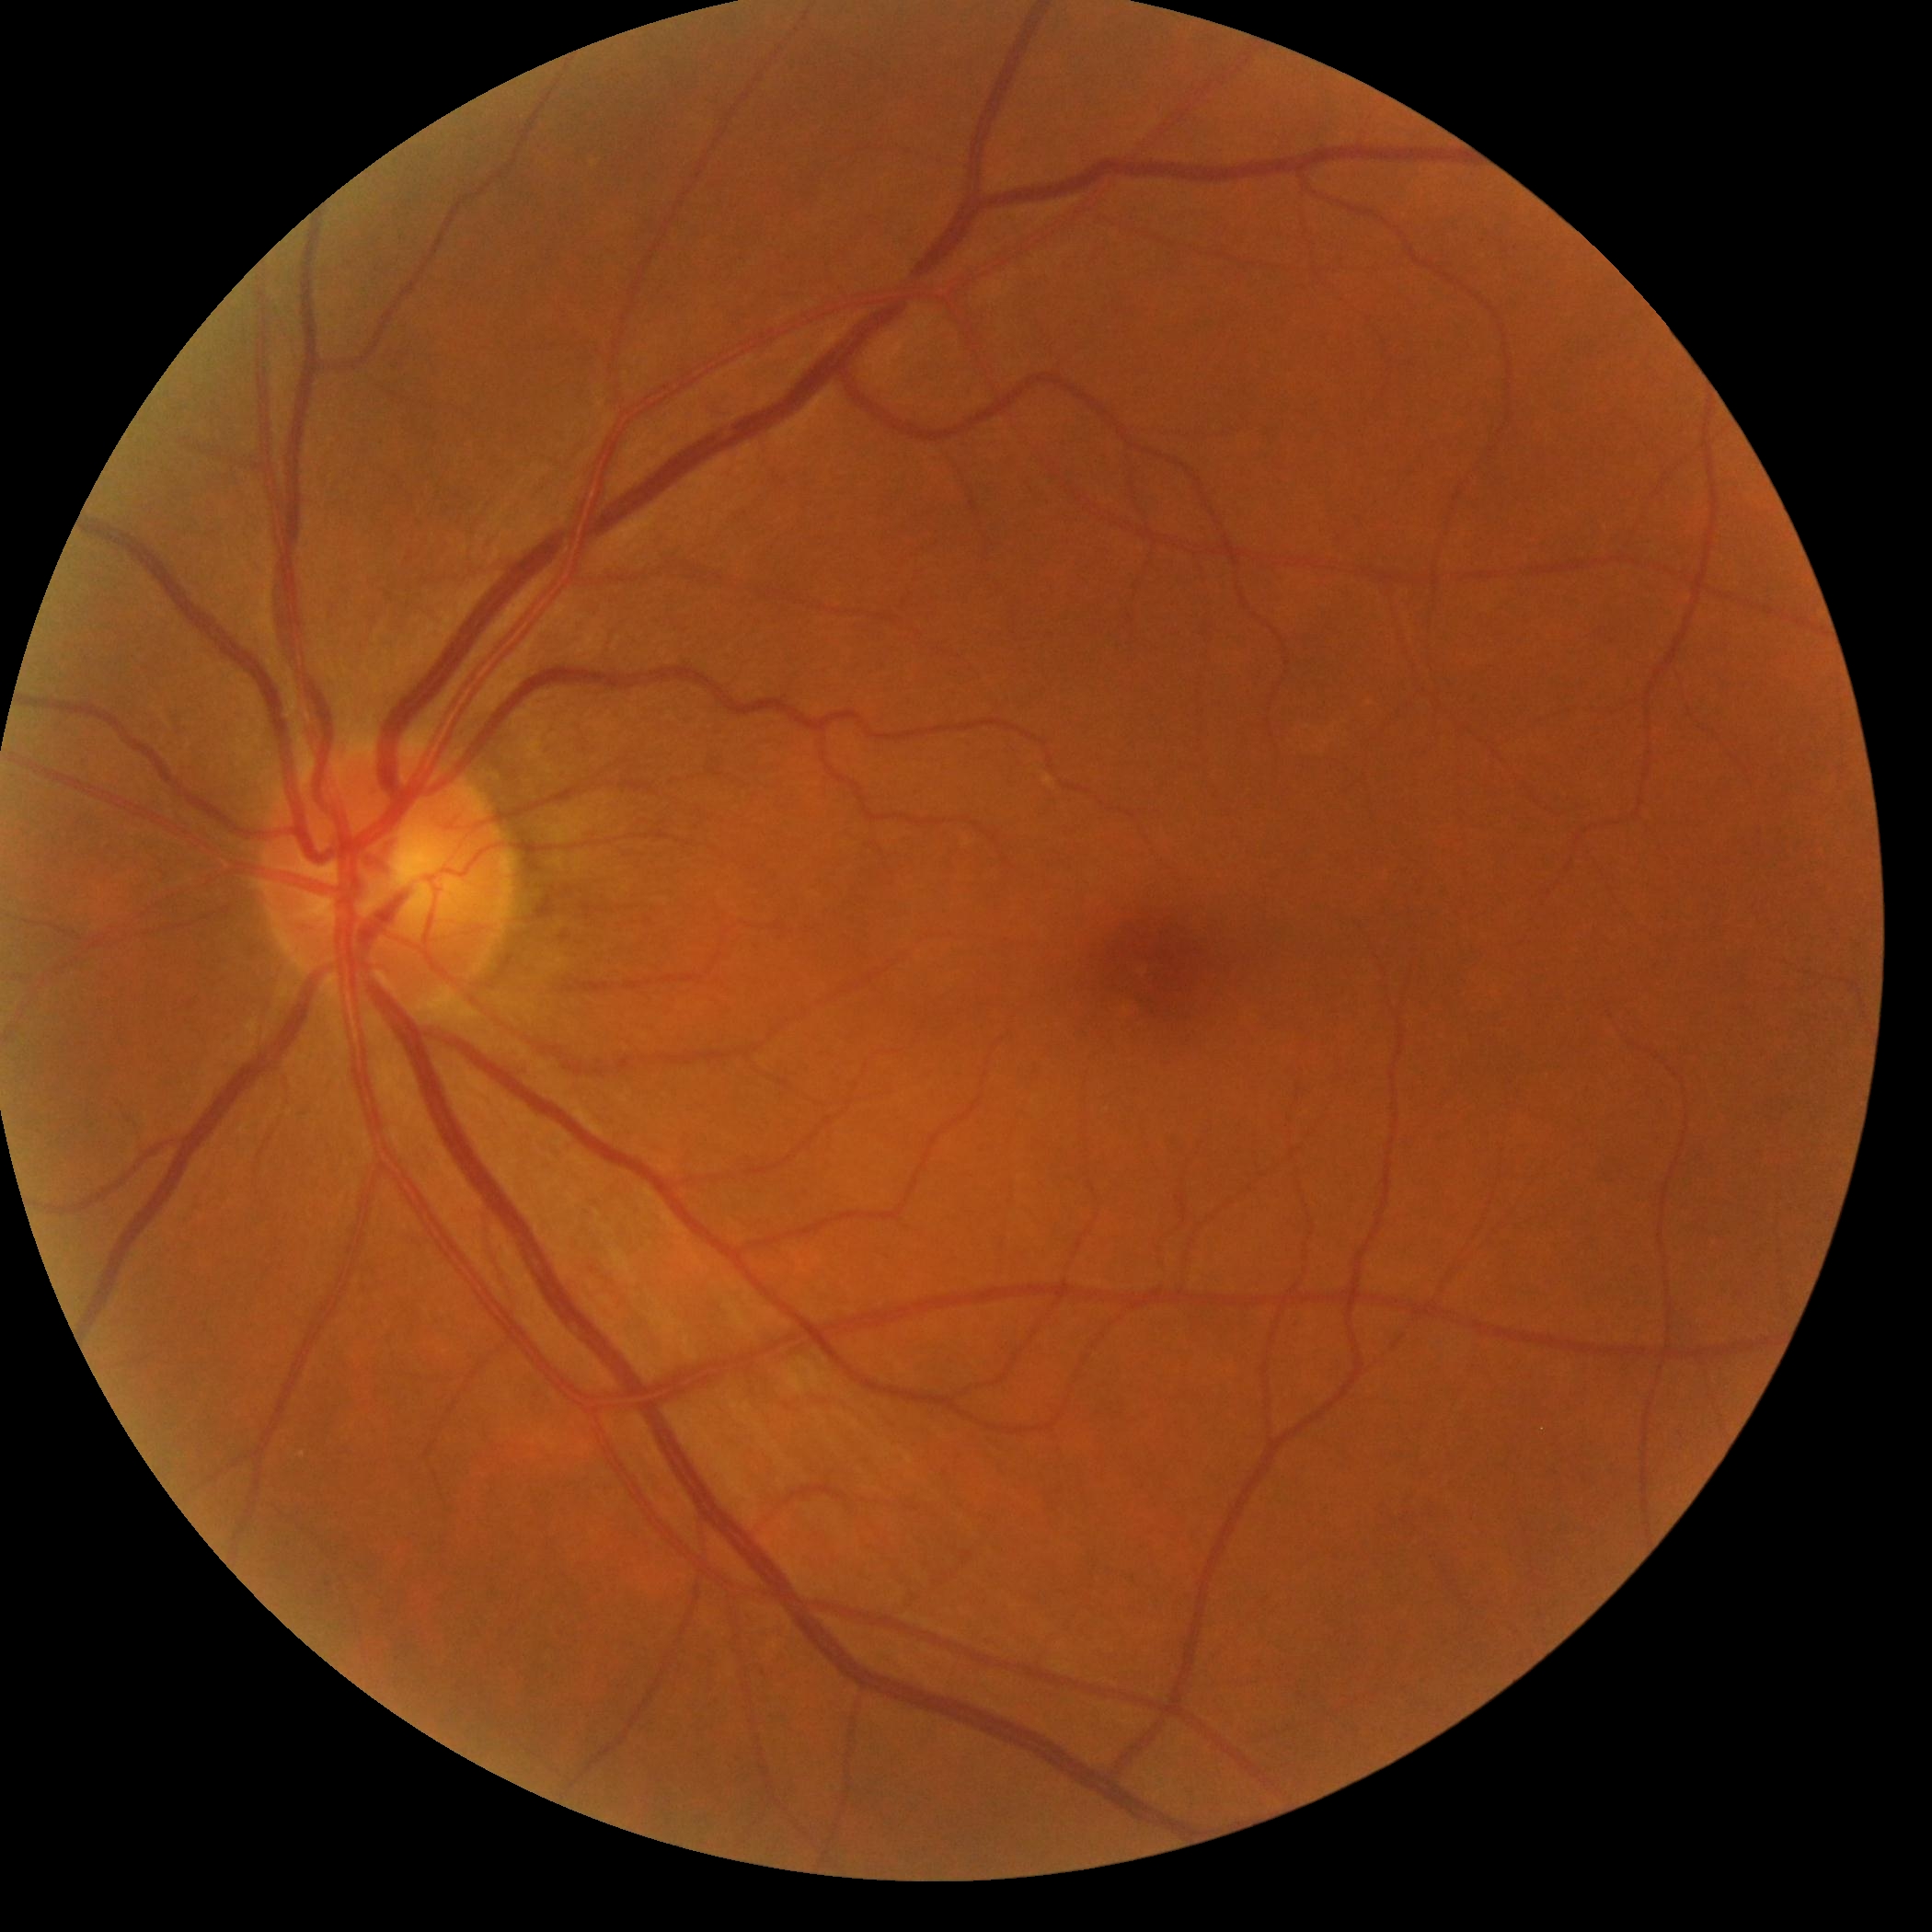

dr_grade: 0 (no apparent retinopathy)